Pediatric wide-field fundus photograph. Image size 1240x1240 — 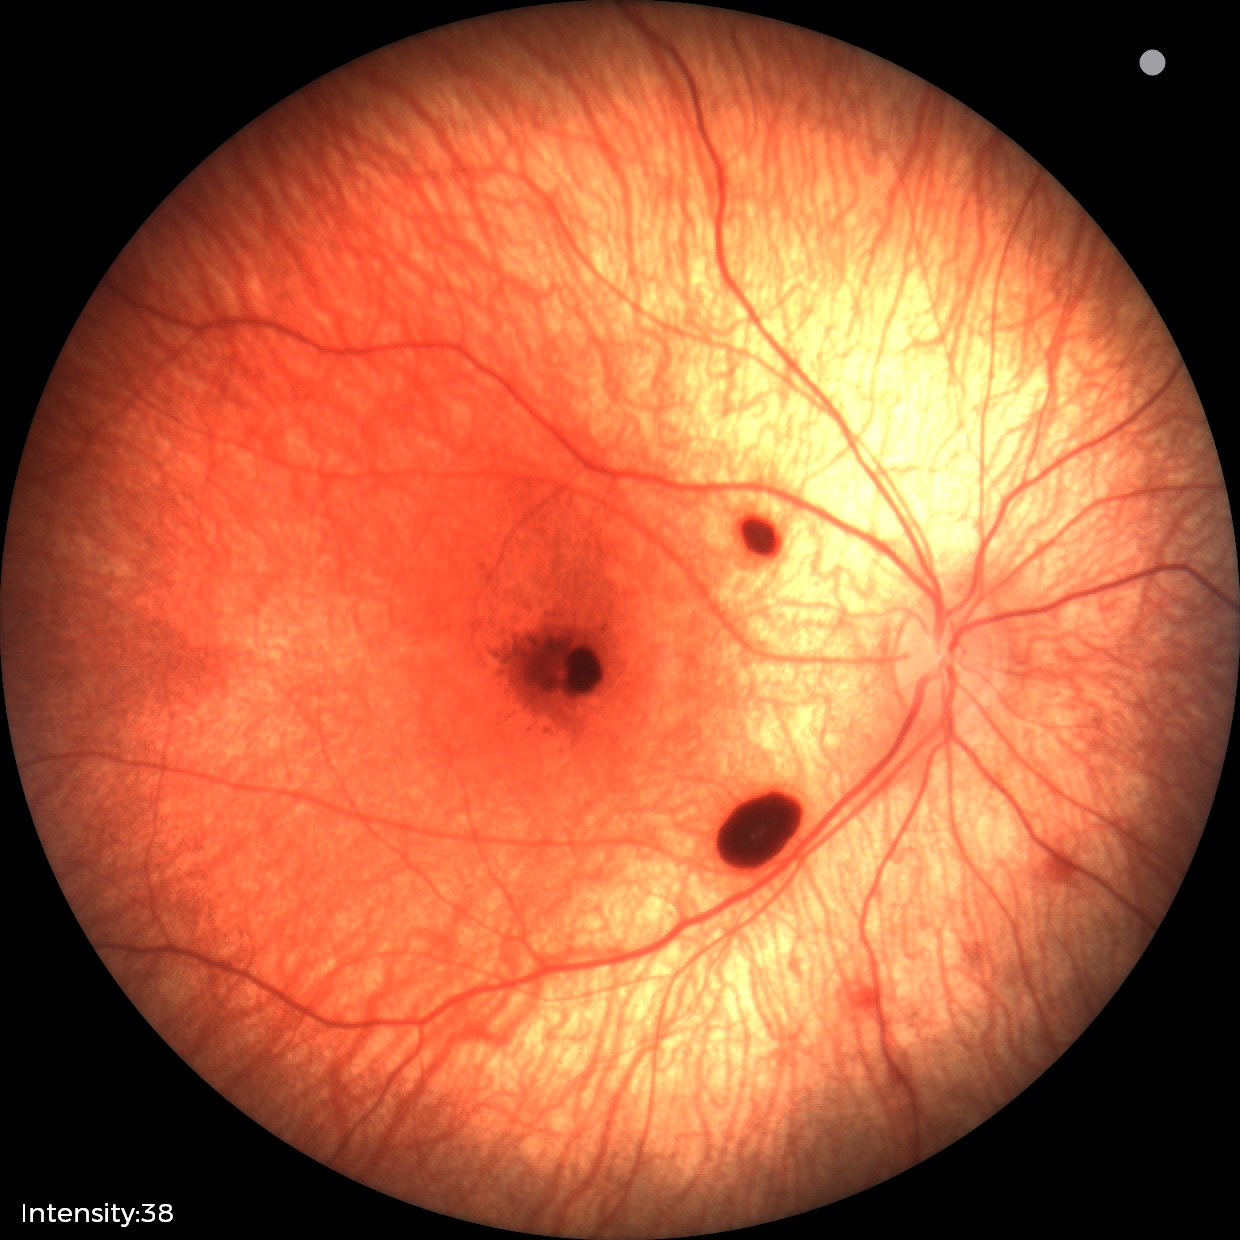 Series diagnosed as retinal hemorrhages.